640x480. RetCam wide-field infant fundus image:
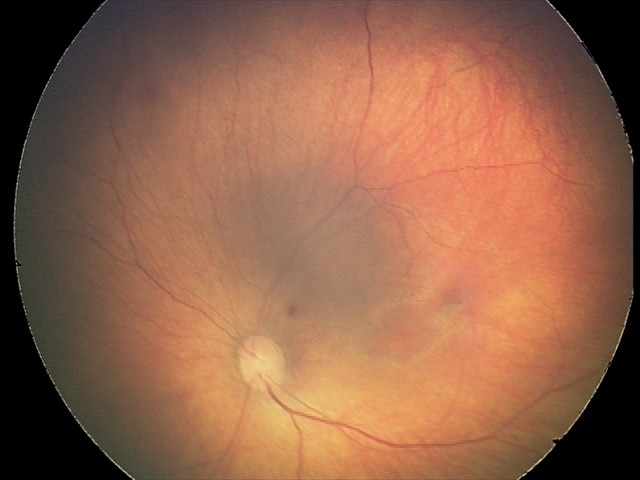

Screening series with retinal hemorrhages.